Retinal fundus photograph: 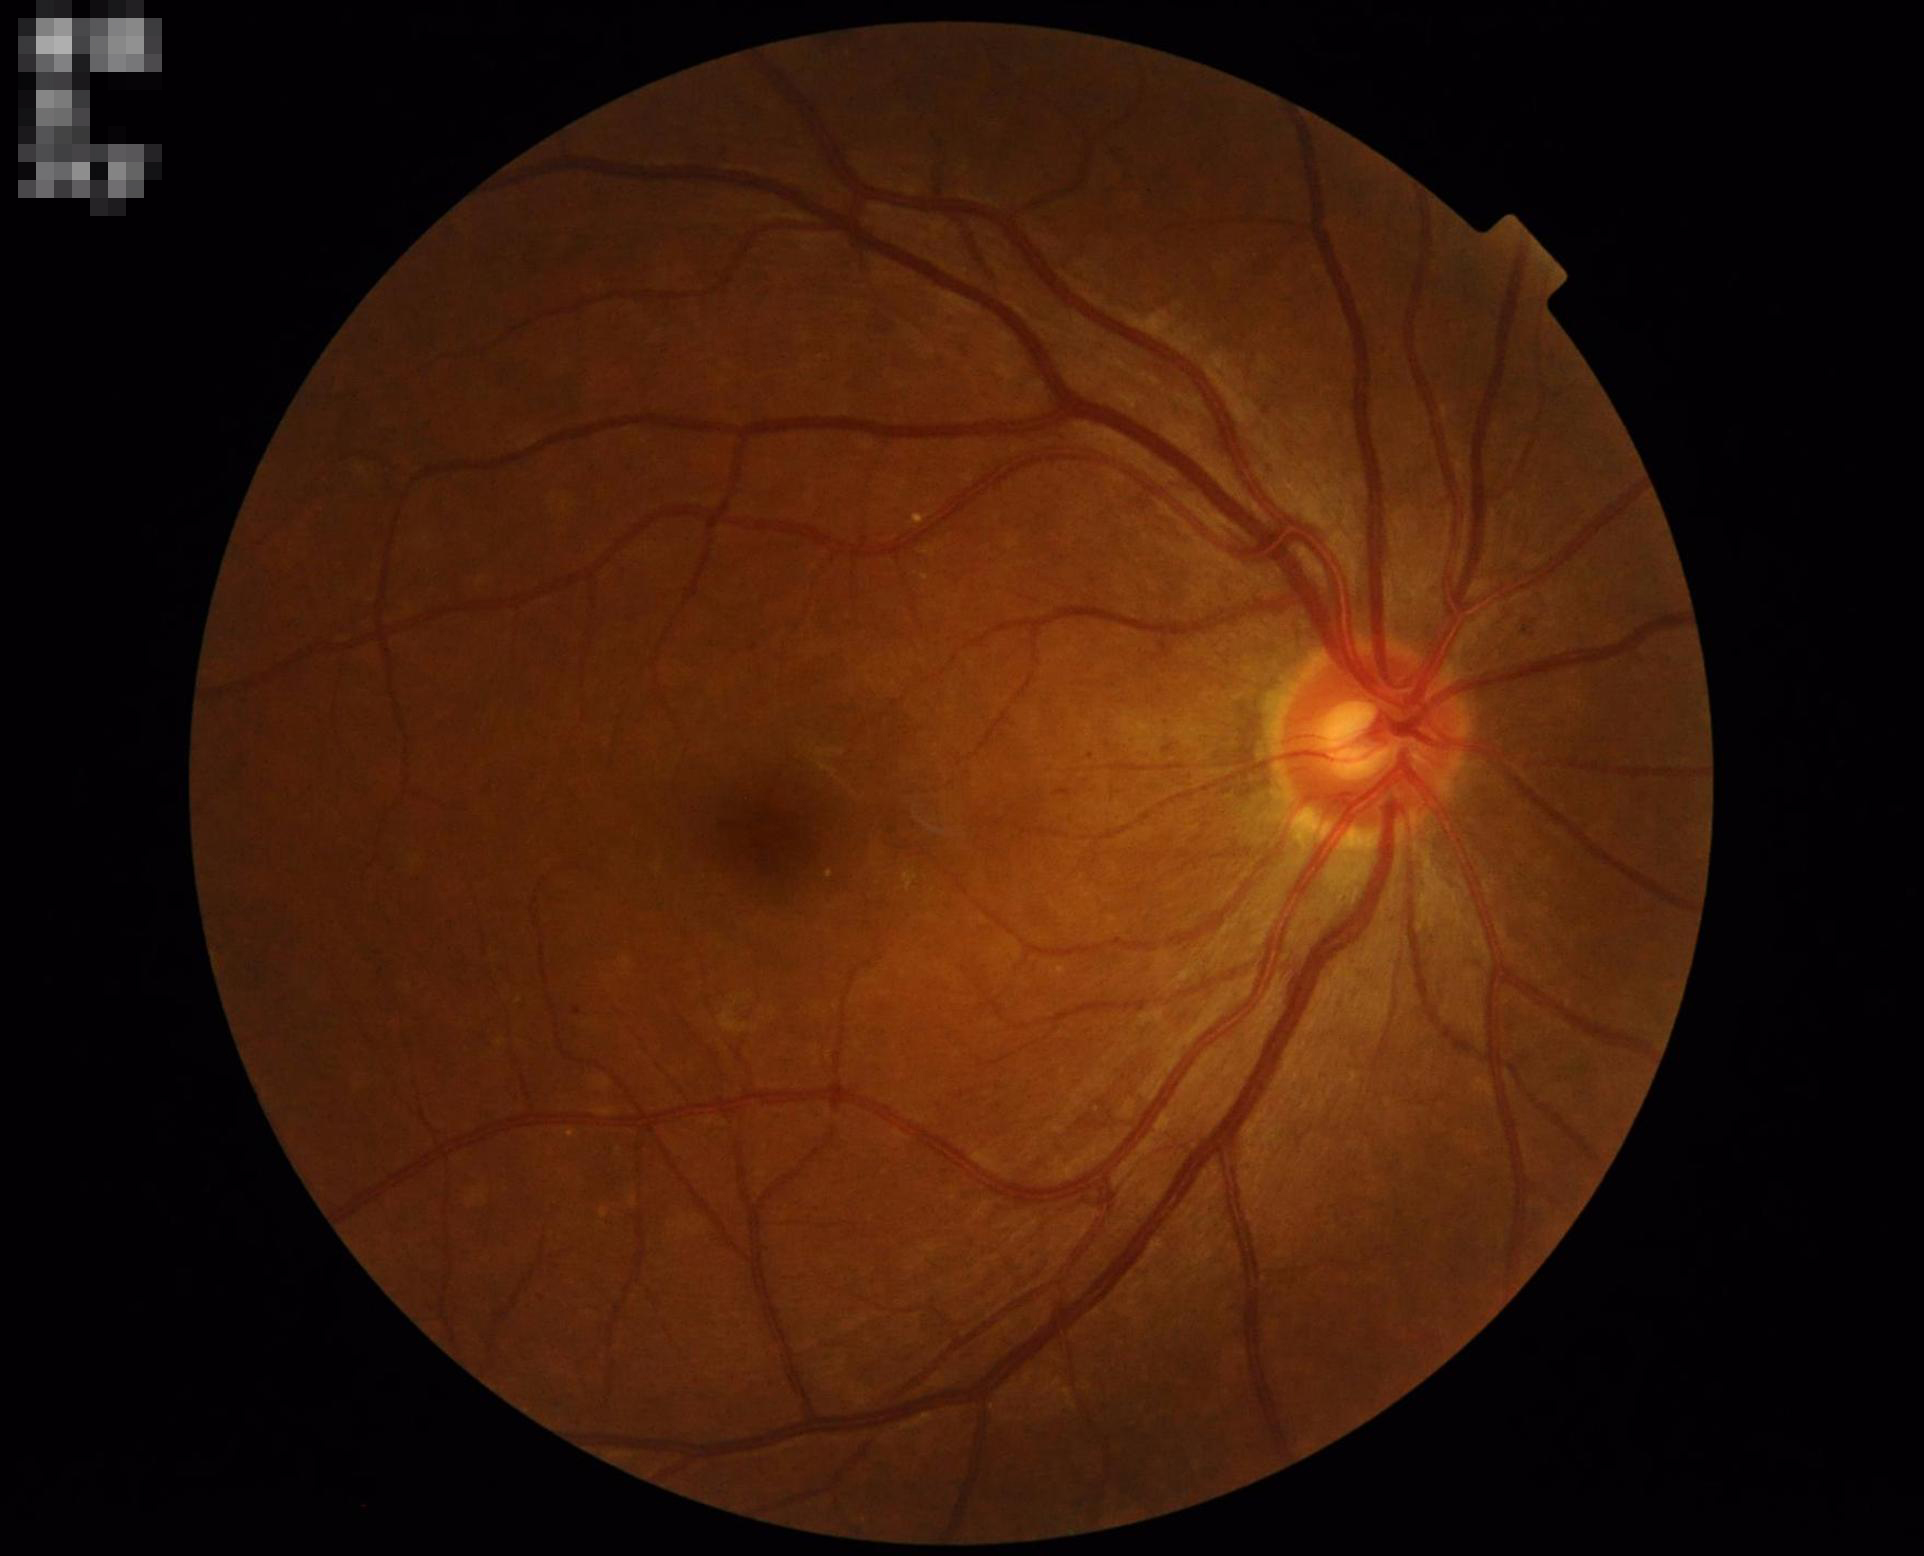
Illumination: even and well-balanced; Overall quality: adequate for clinical interpretation; Contrast: vessels and details readily distinguishable; Clarity: optic disc, vessels, and background in focus.